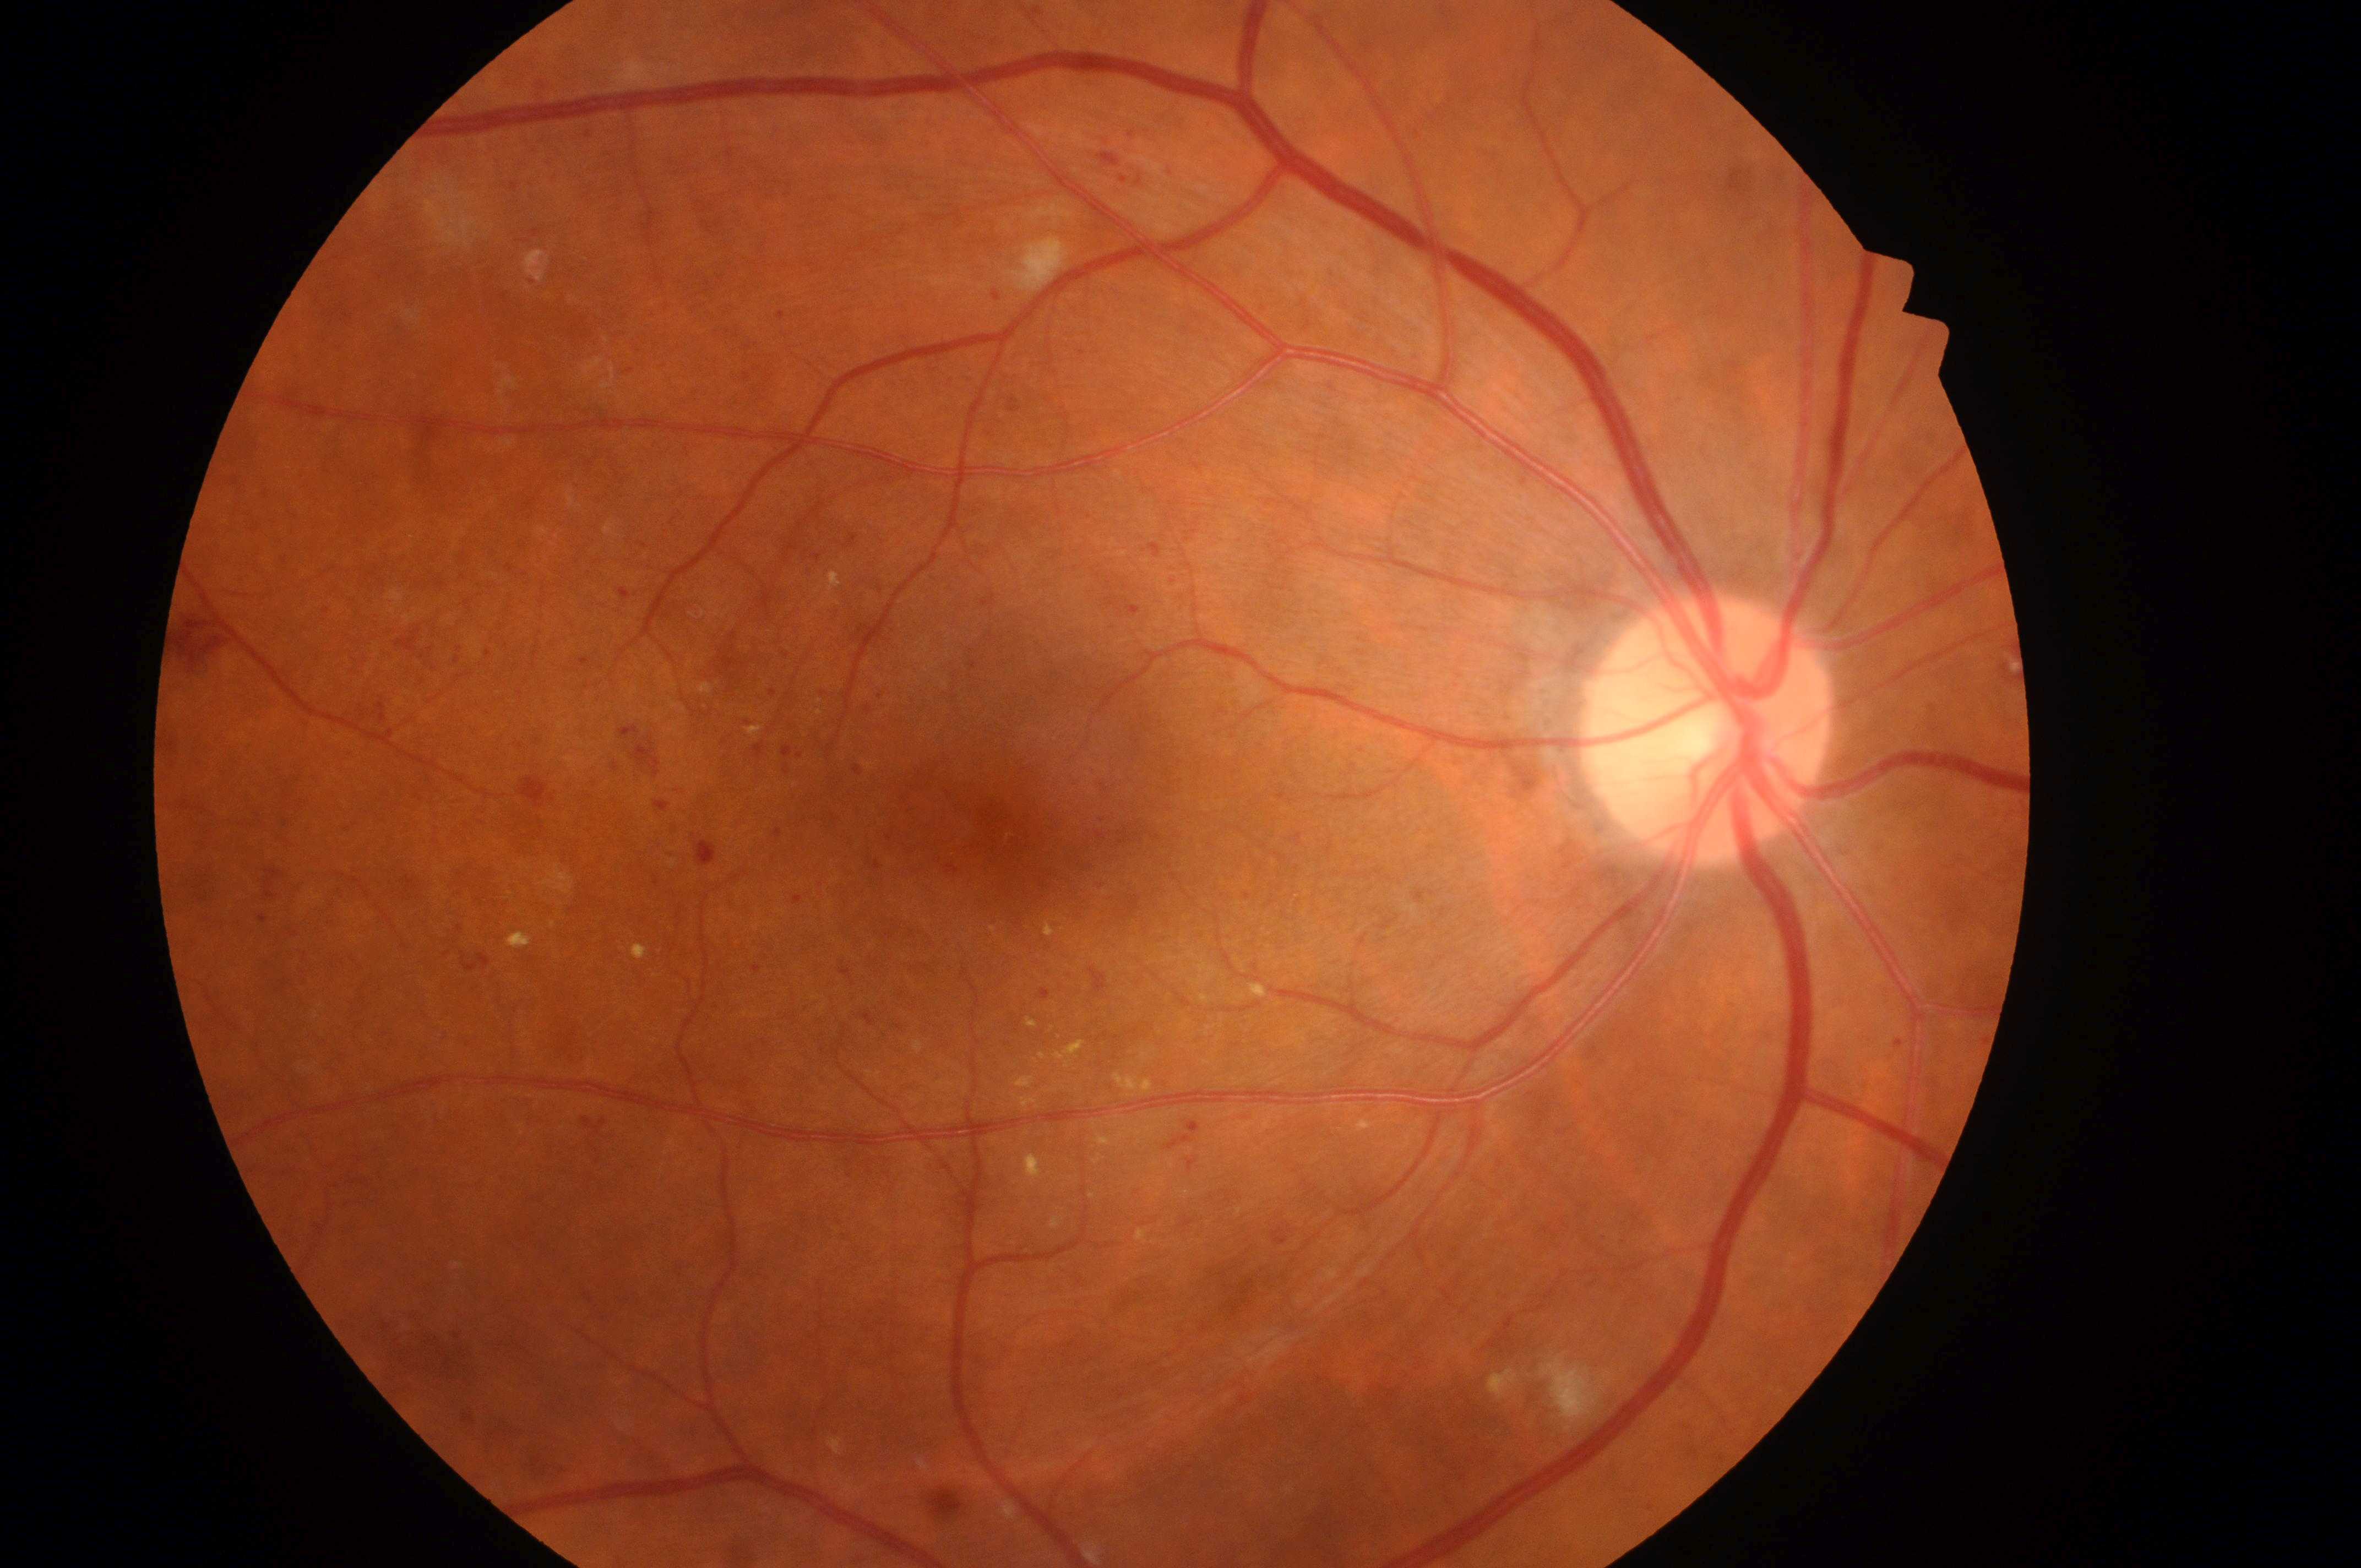 – laterality — right eye
– macular edema — 2
– ONH — (1706,738)
– the fovea — (992,829)
– diabetic retinopathy grade — 3